1240 by 1240 pixels; pediatric retinal photograph (wide-field) — 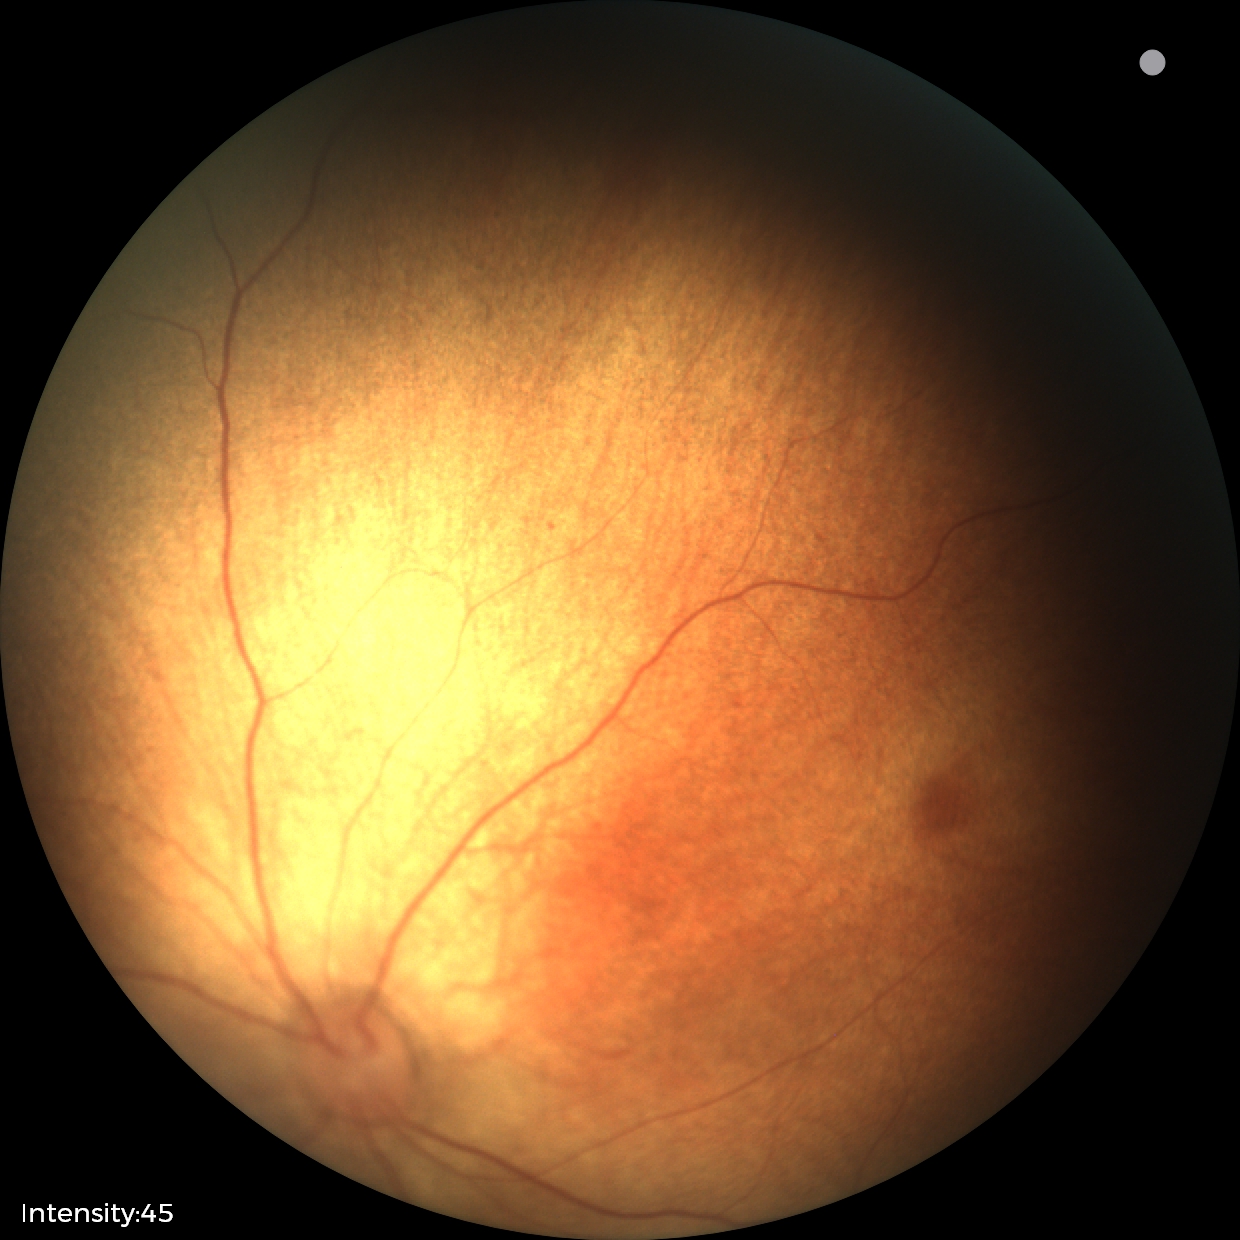
Screening examination diagnosed as physiological.